45 degree fundus photograph; modified Davis grading; color fundus image.
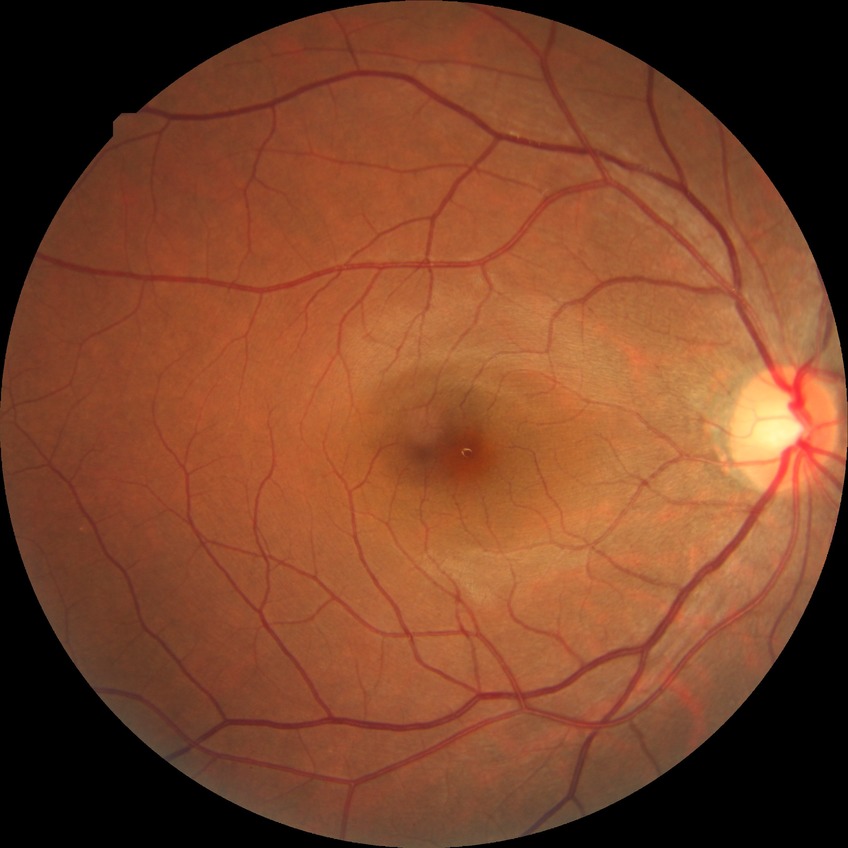

diabetic retinopathy grade = no diabetic retinopathy.